Color fundus photograph:
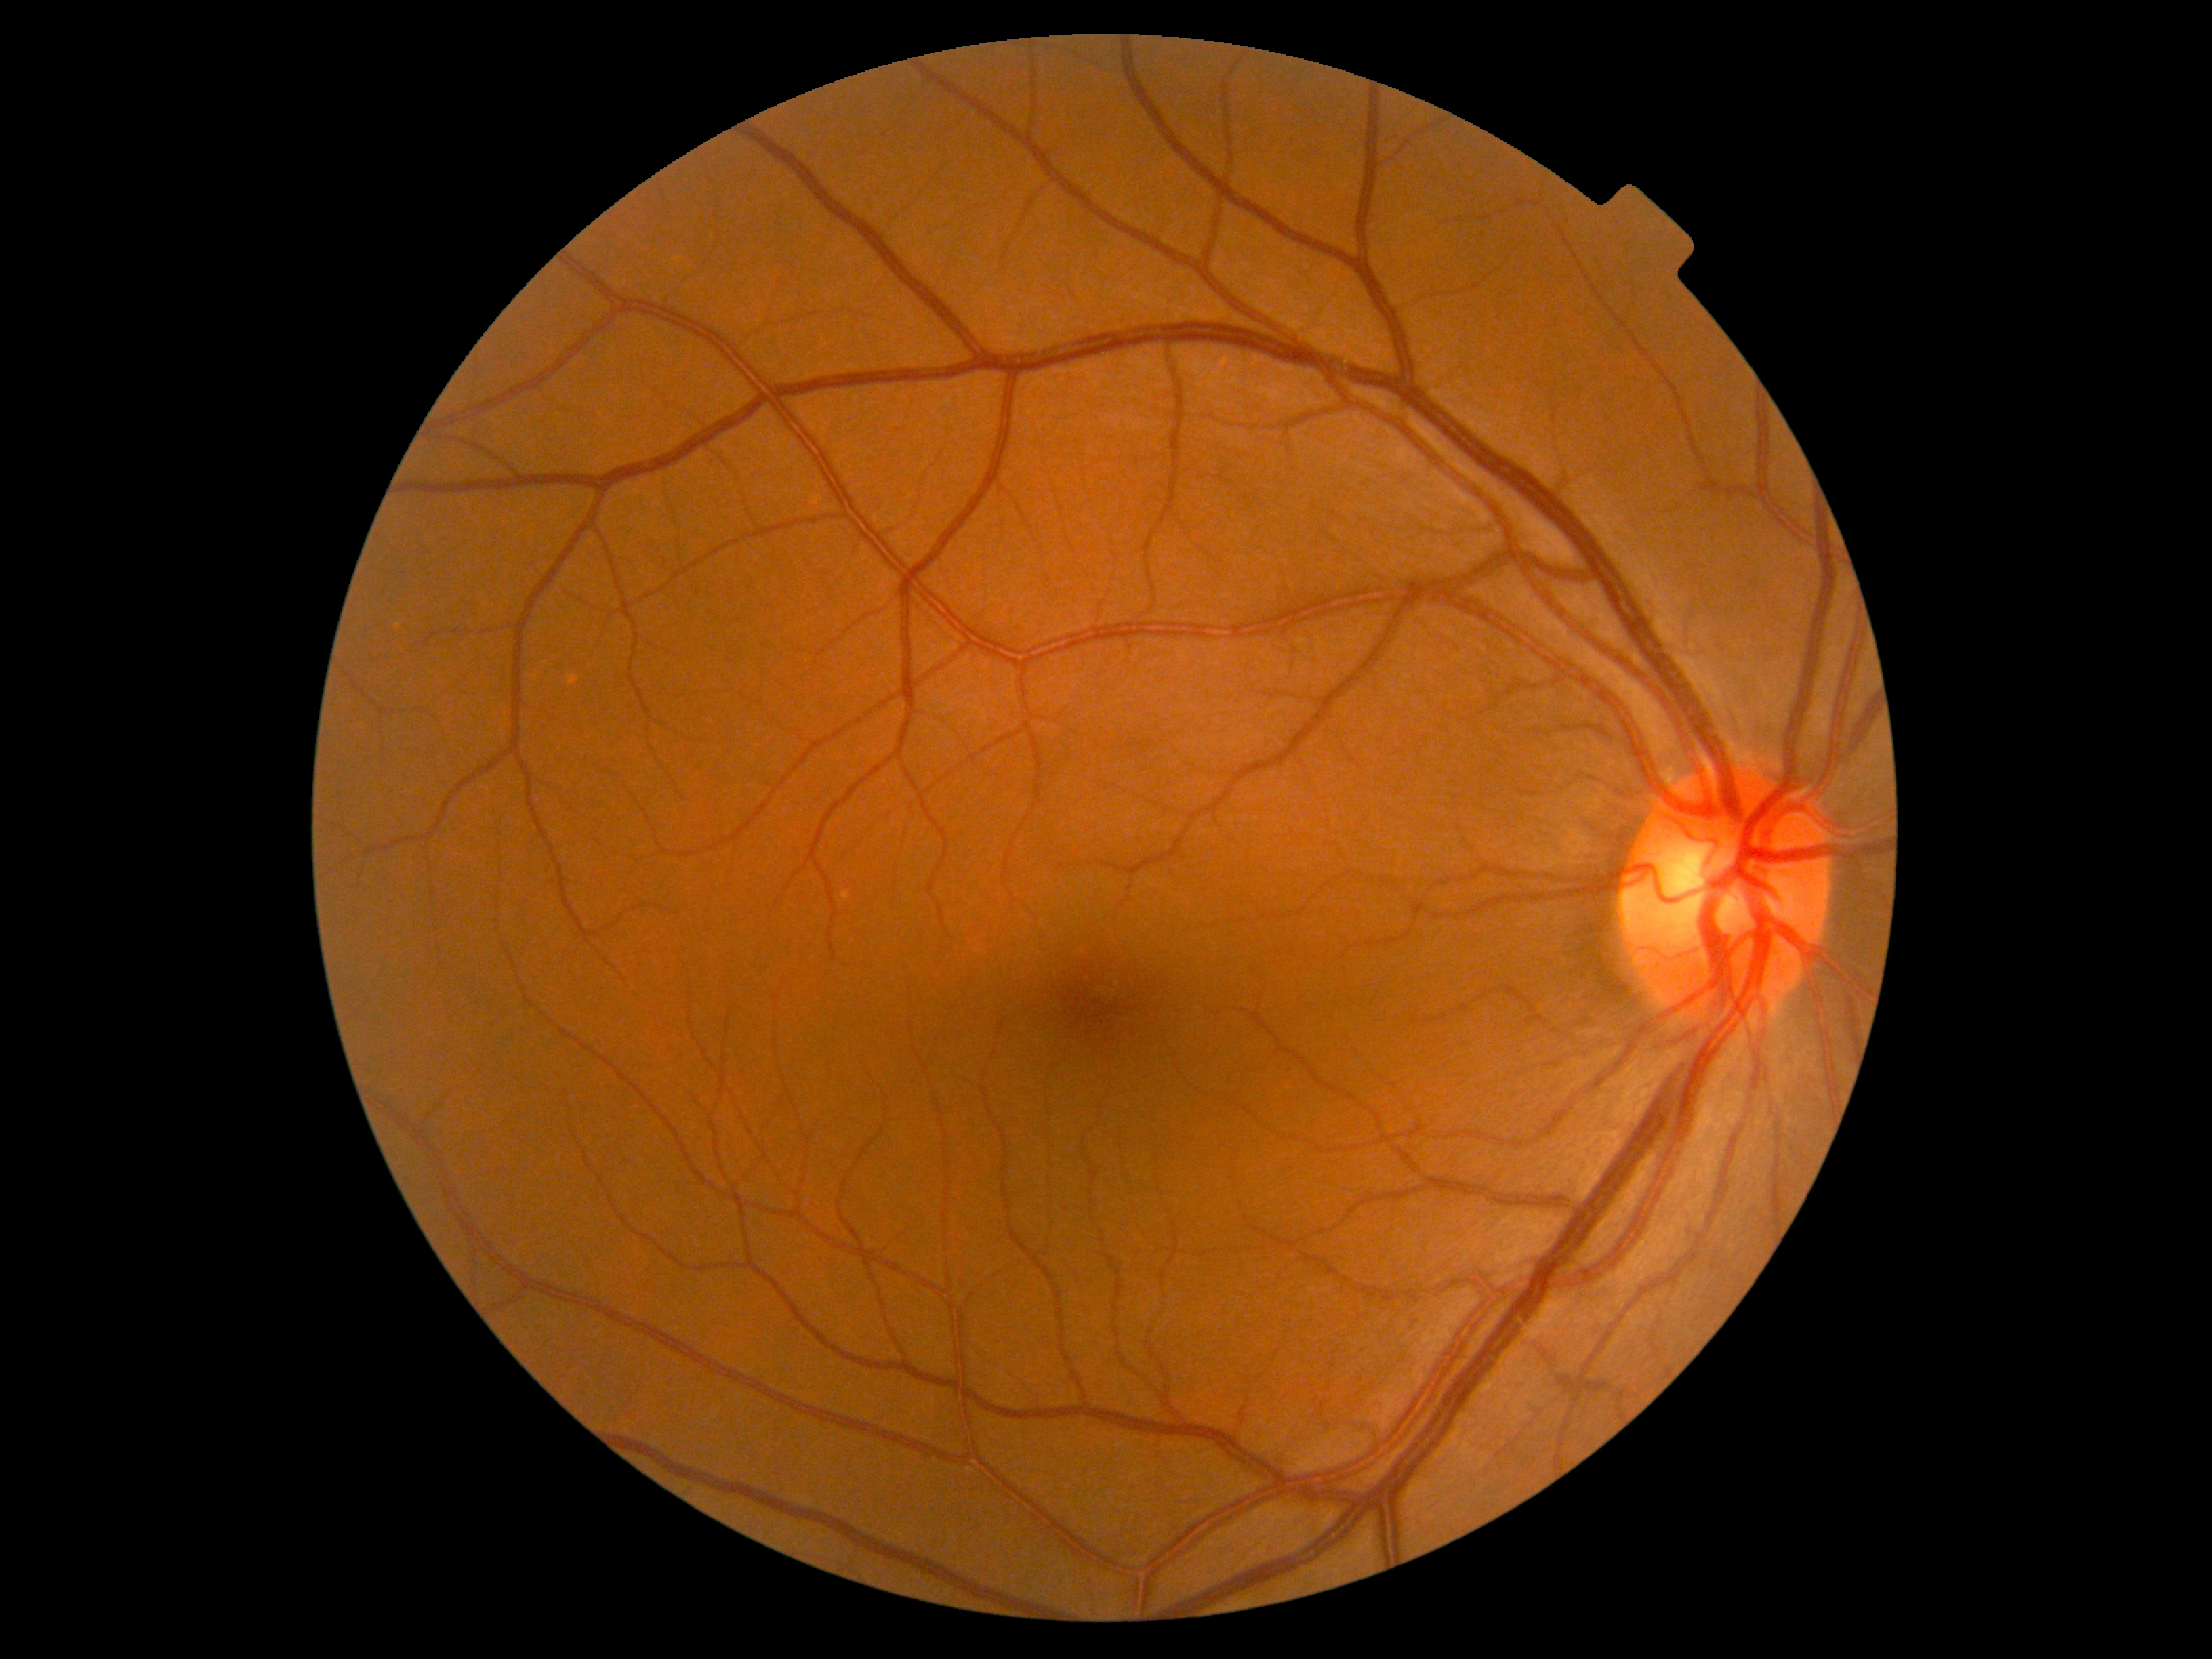 DR severity: grade 0 (no apparent retinopathy).